CFP. Optic disc at the center of the field. 57-year-old patient. Intraocular pressure: 25 mmHg: 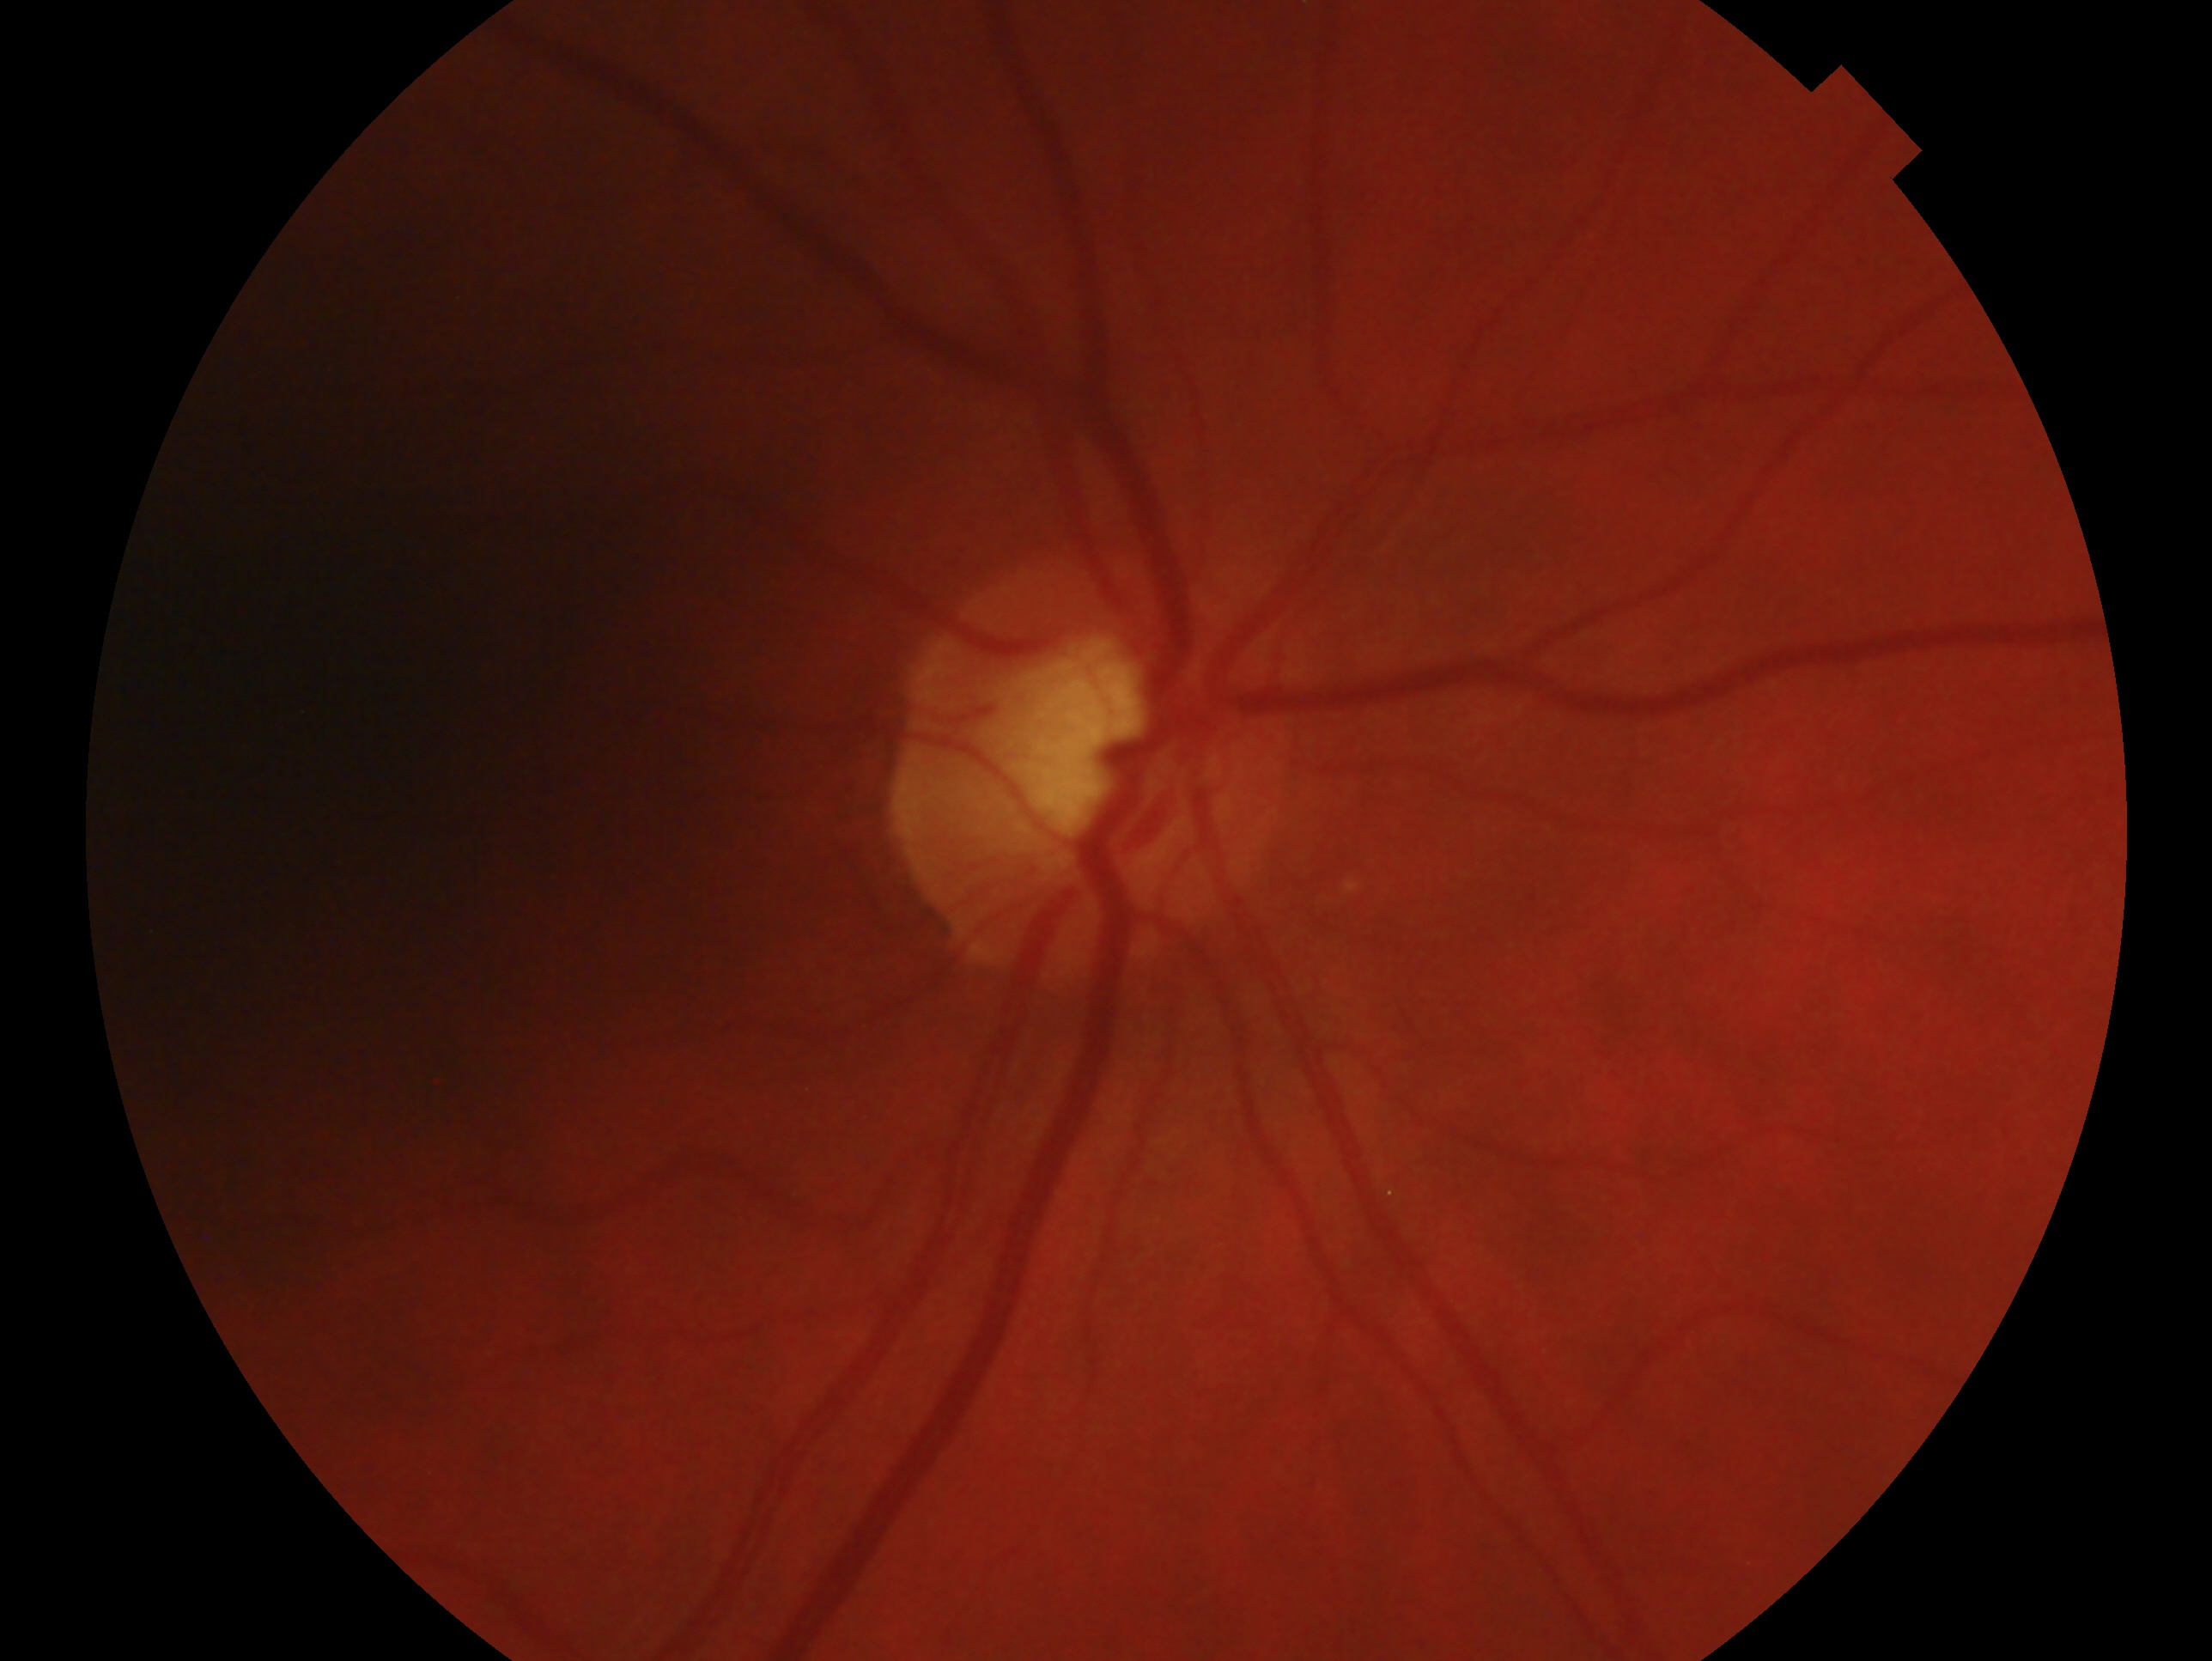

eye: right eye
glaucoma_dx: suspected glaucoma — risk factors or equivocal findings for glaucoma without a confirmed diagnosis